2352x1568 · color fundus image · 45° FOV
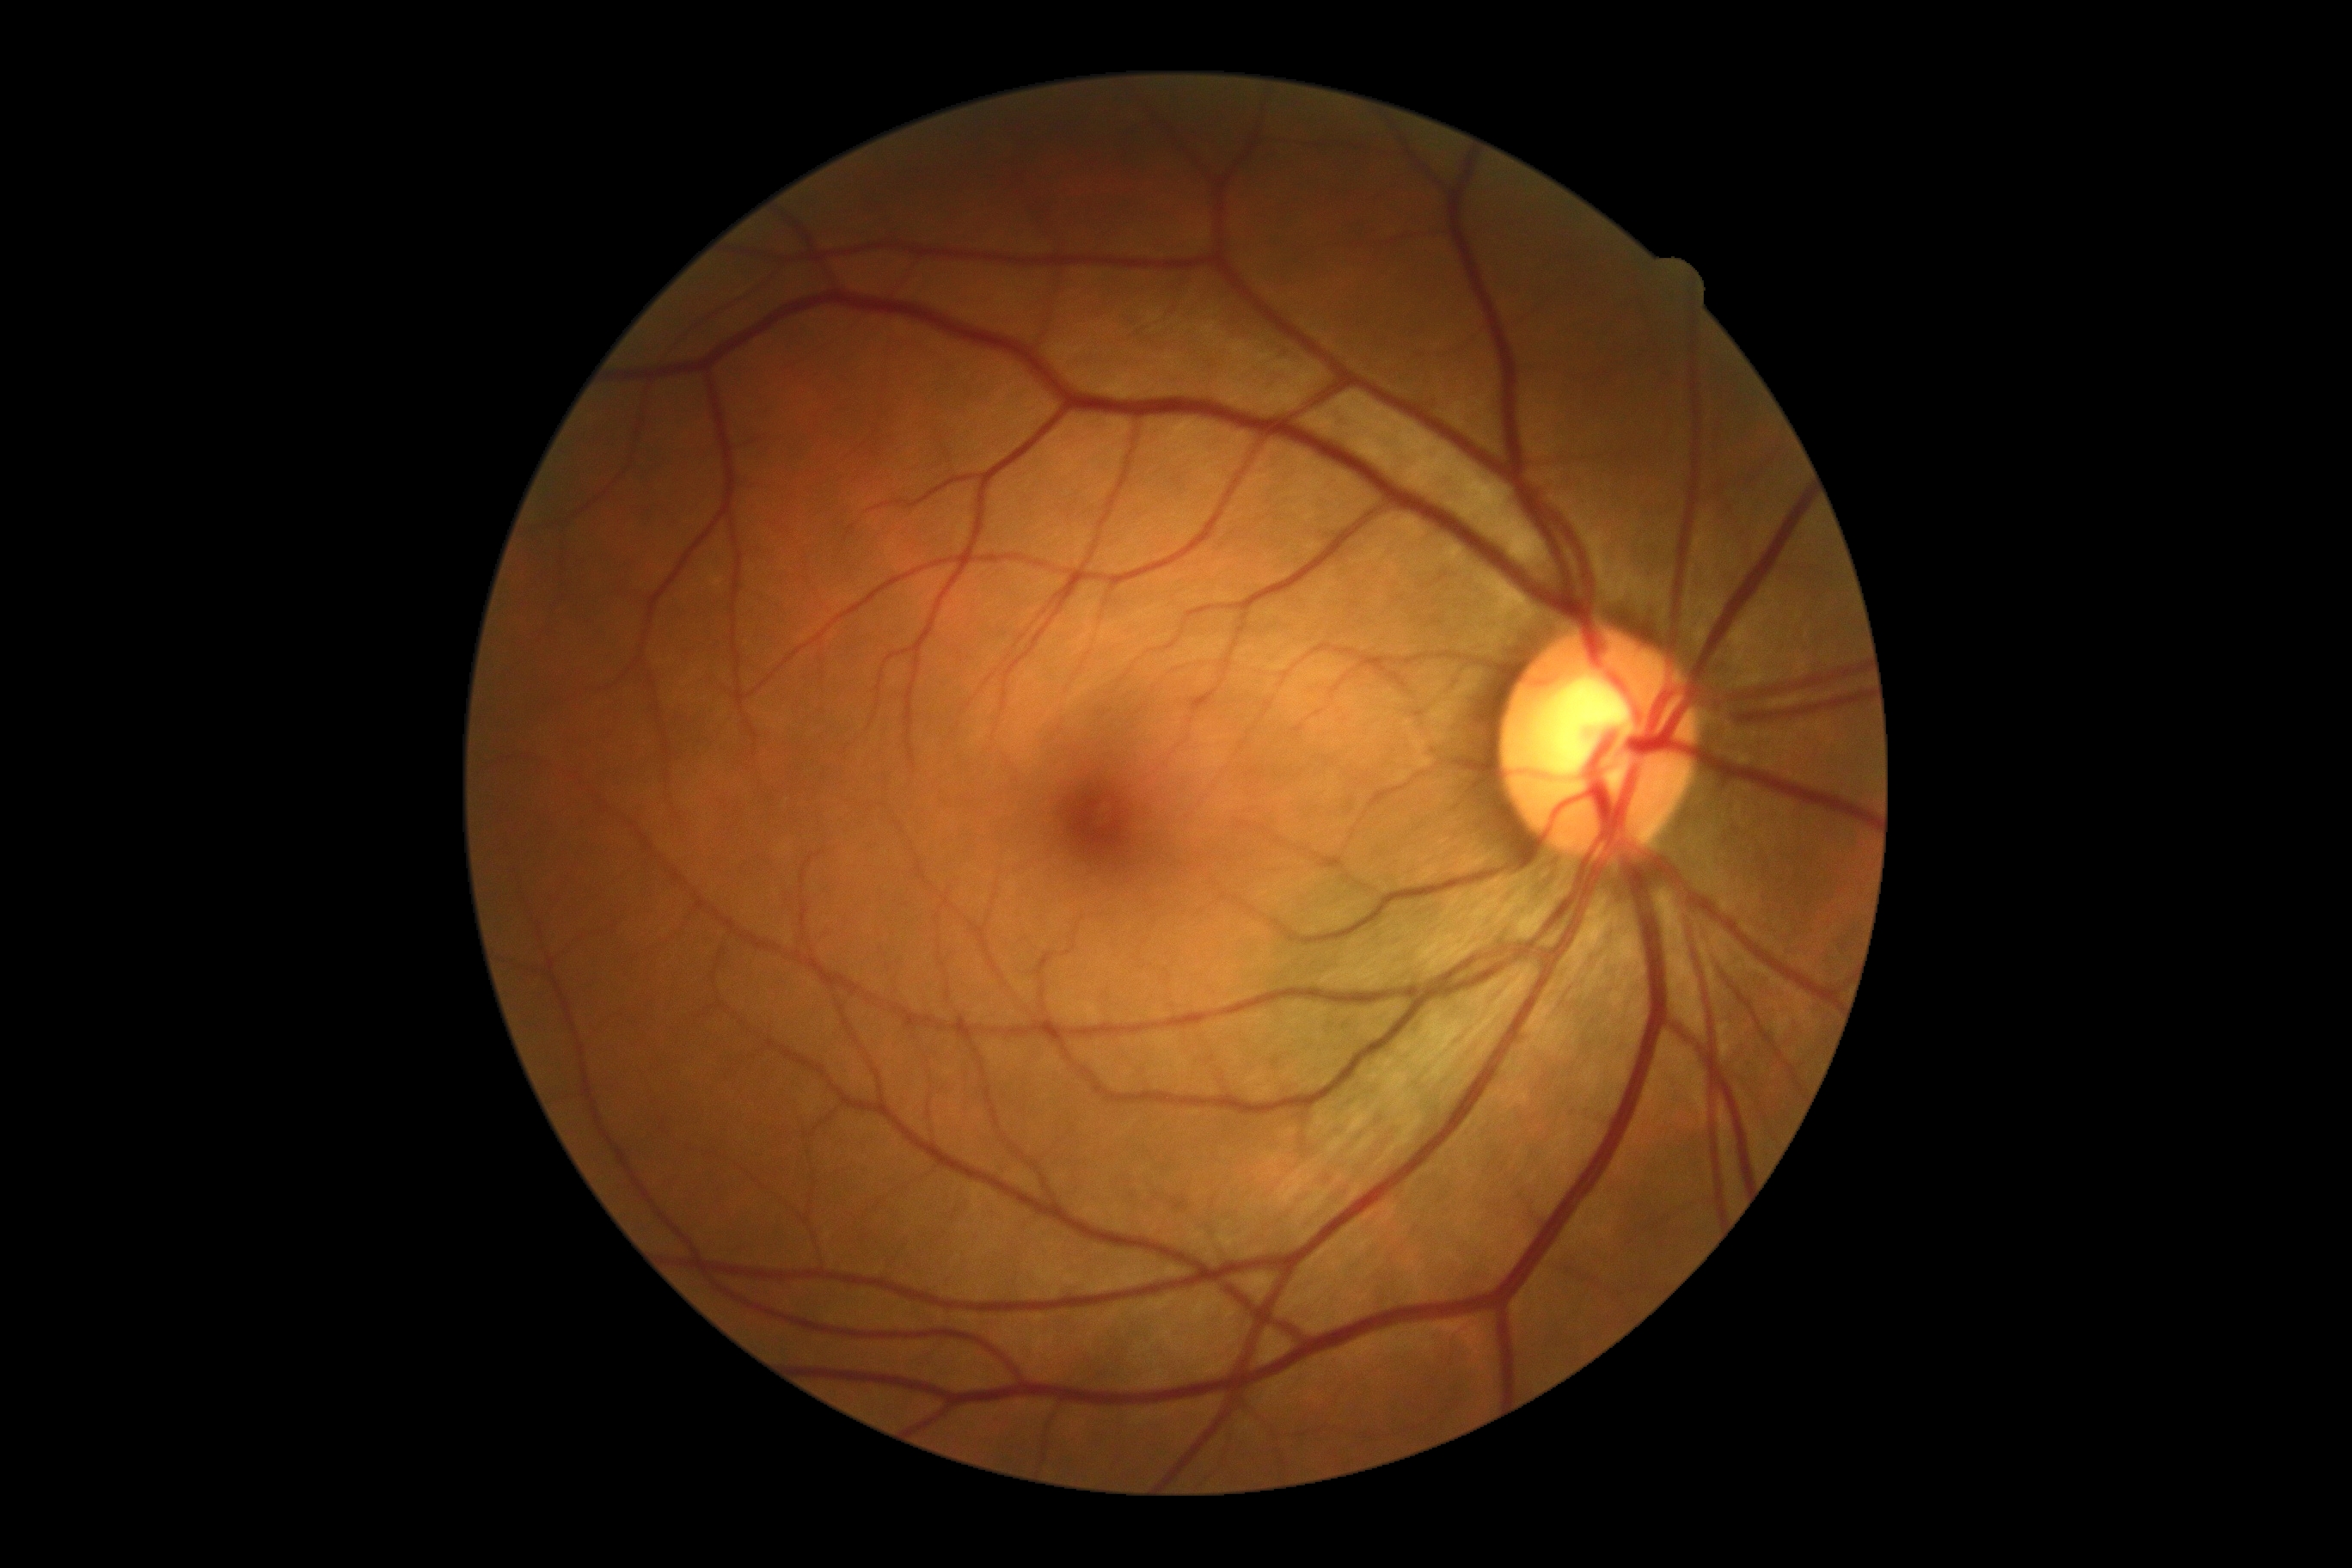

DR stage: grade 0 (no apparent retinopathy). No DR findings.